1240 x 1240 pixels. Infant wide-field retinal image.
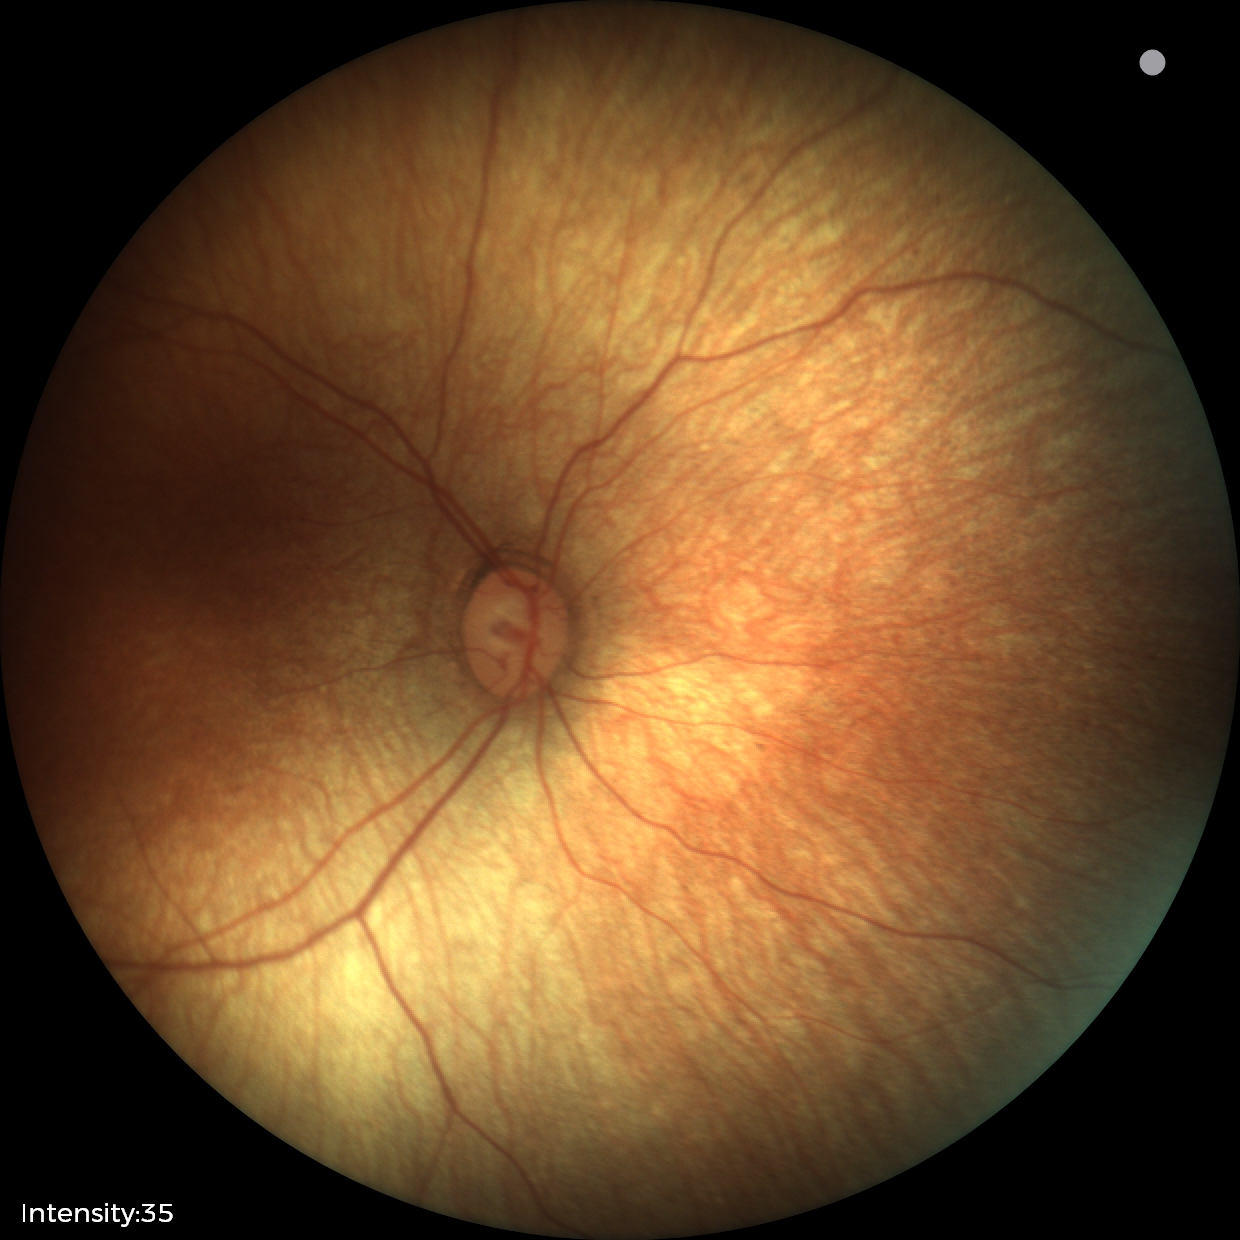 Normal screening examination.